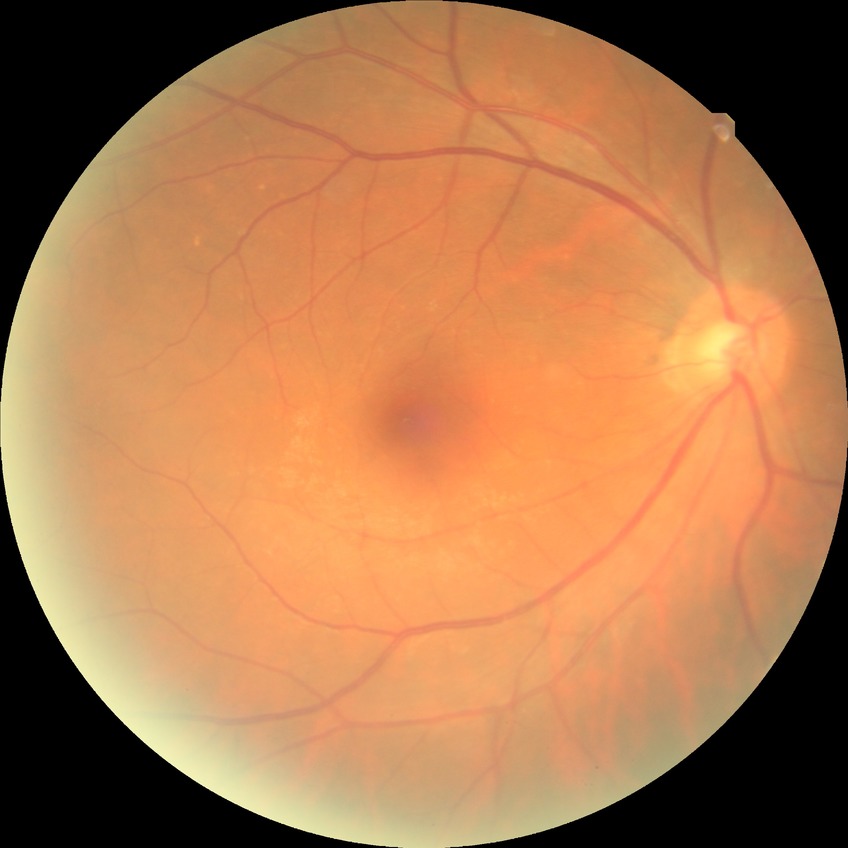 DR severity is NDR. No DR findings.